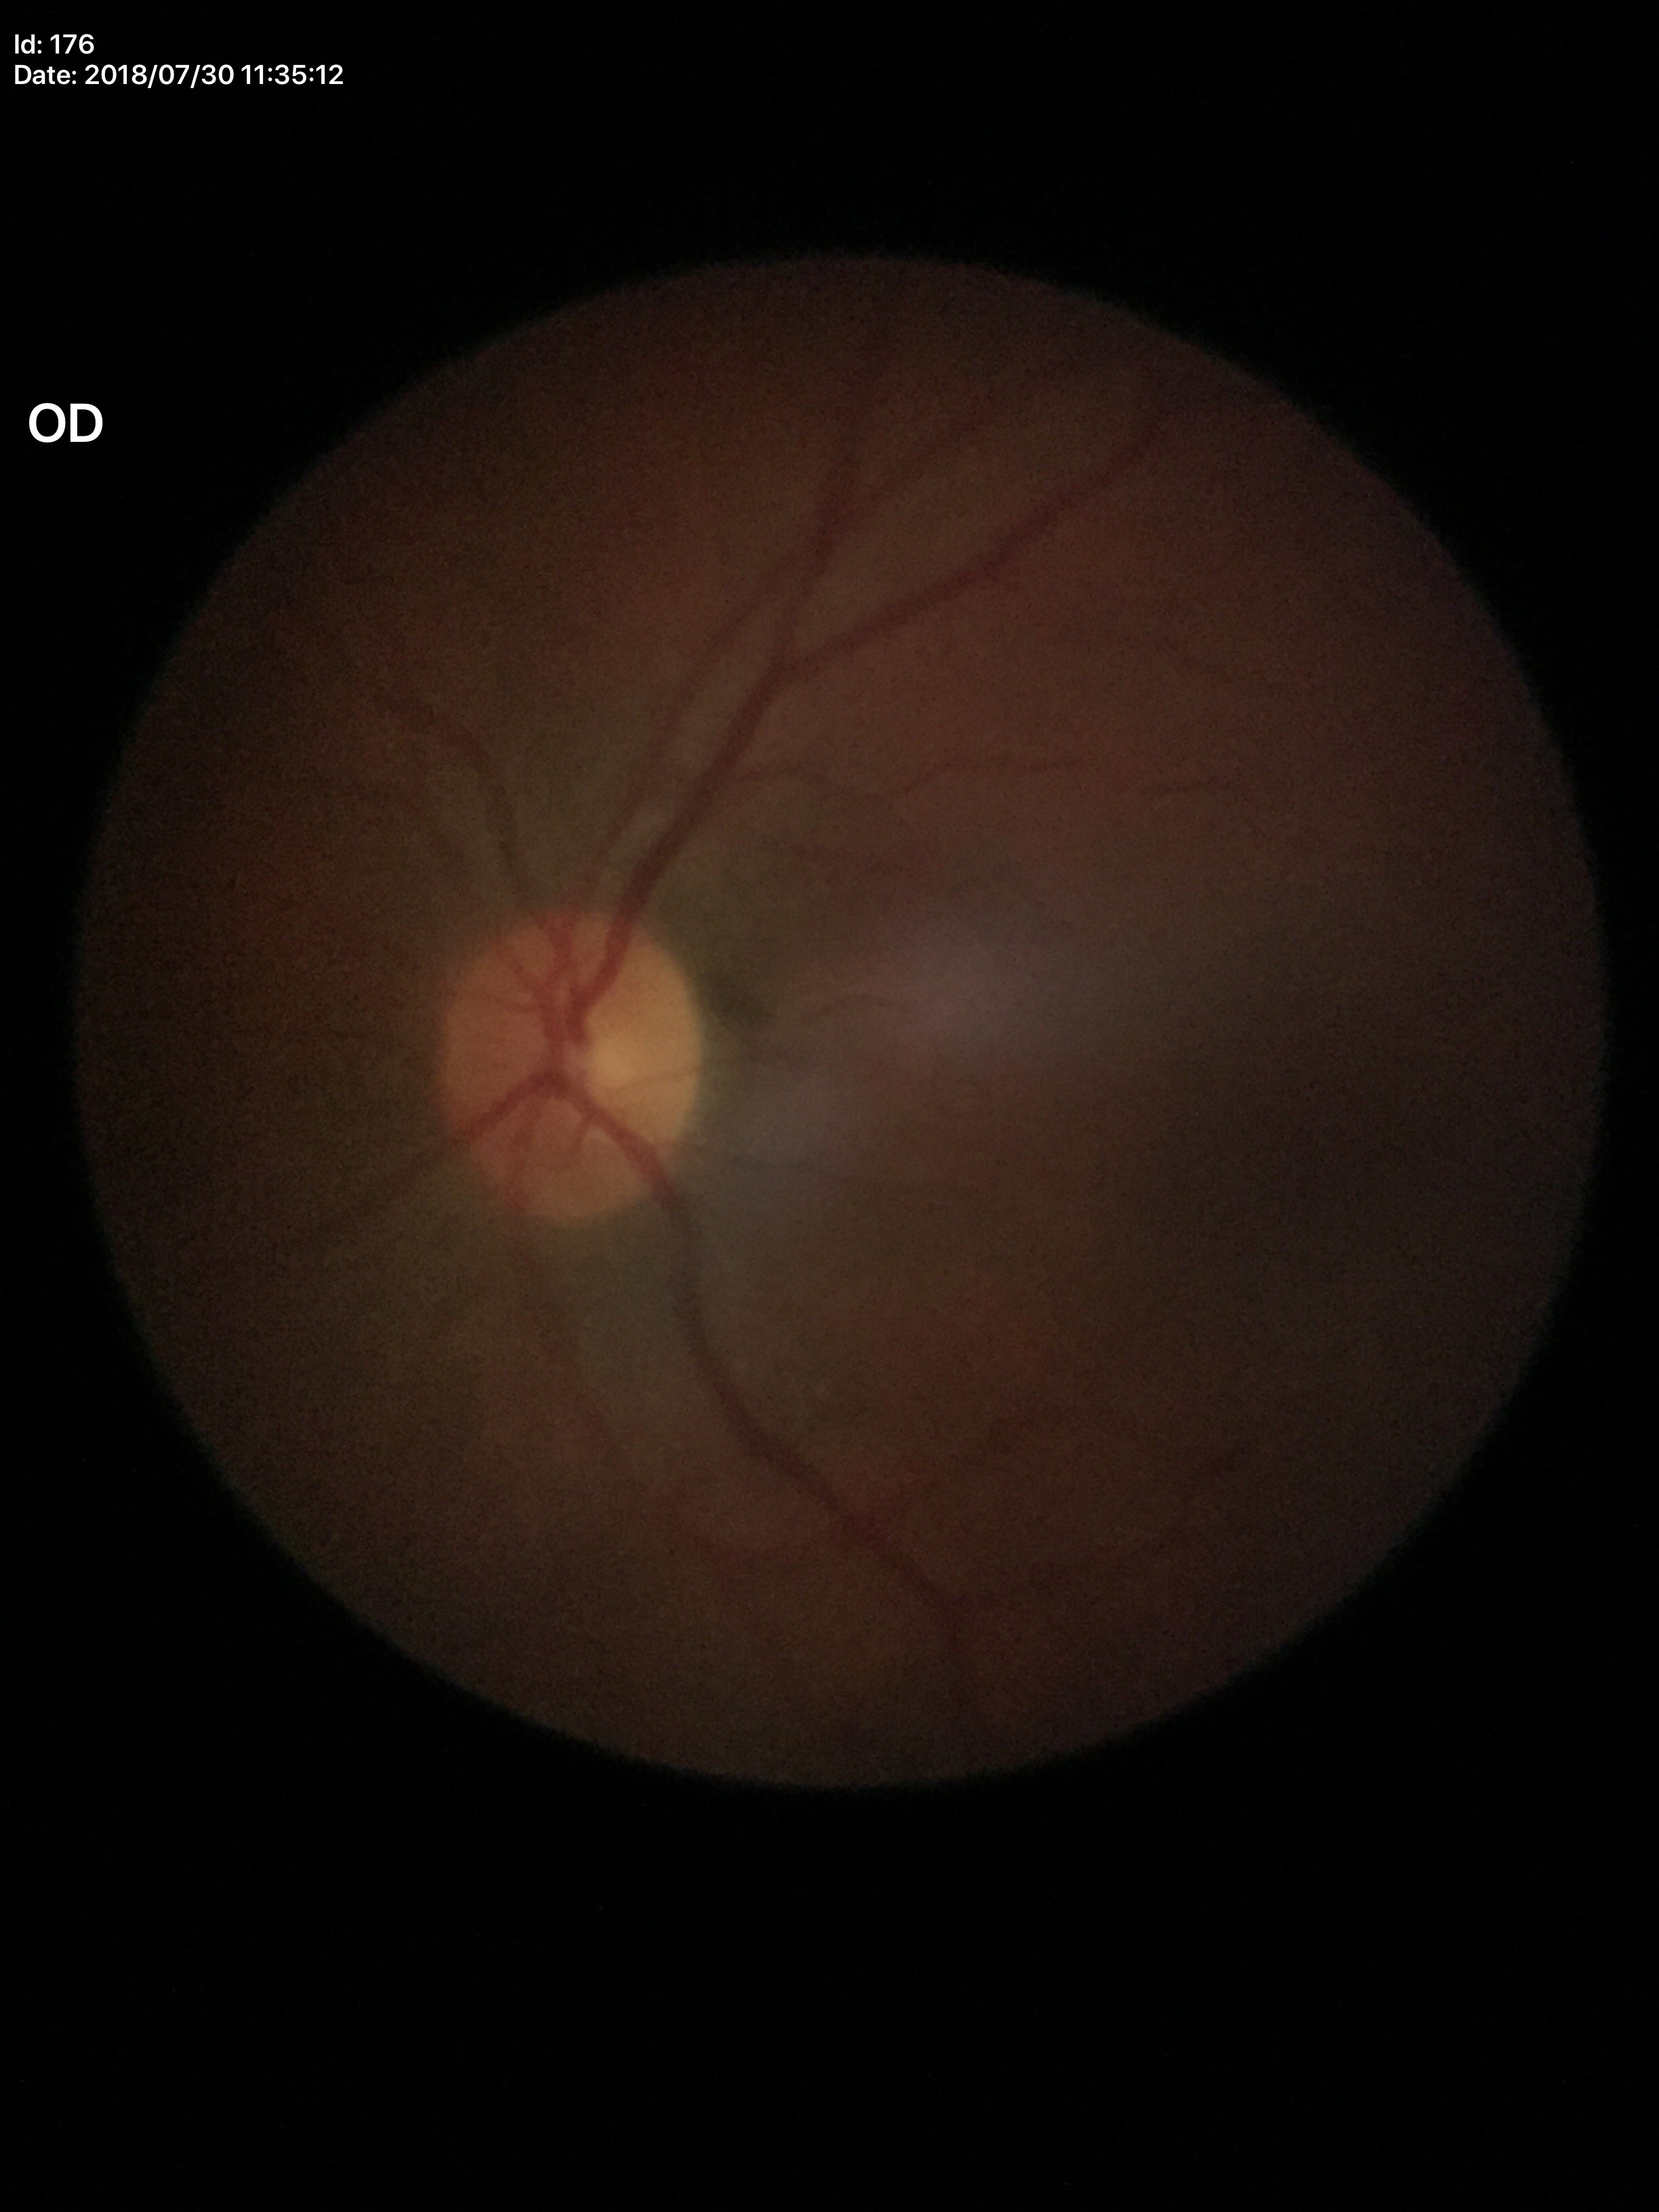 Horizontal CDR (HCDR): 0.46.
Vertical cup-to-disc ratio (VCDR) is 0.43.
Glaucoma impression: not suspect (all 5 graders called normal).